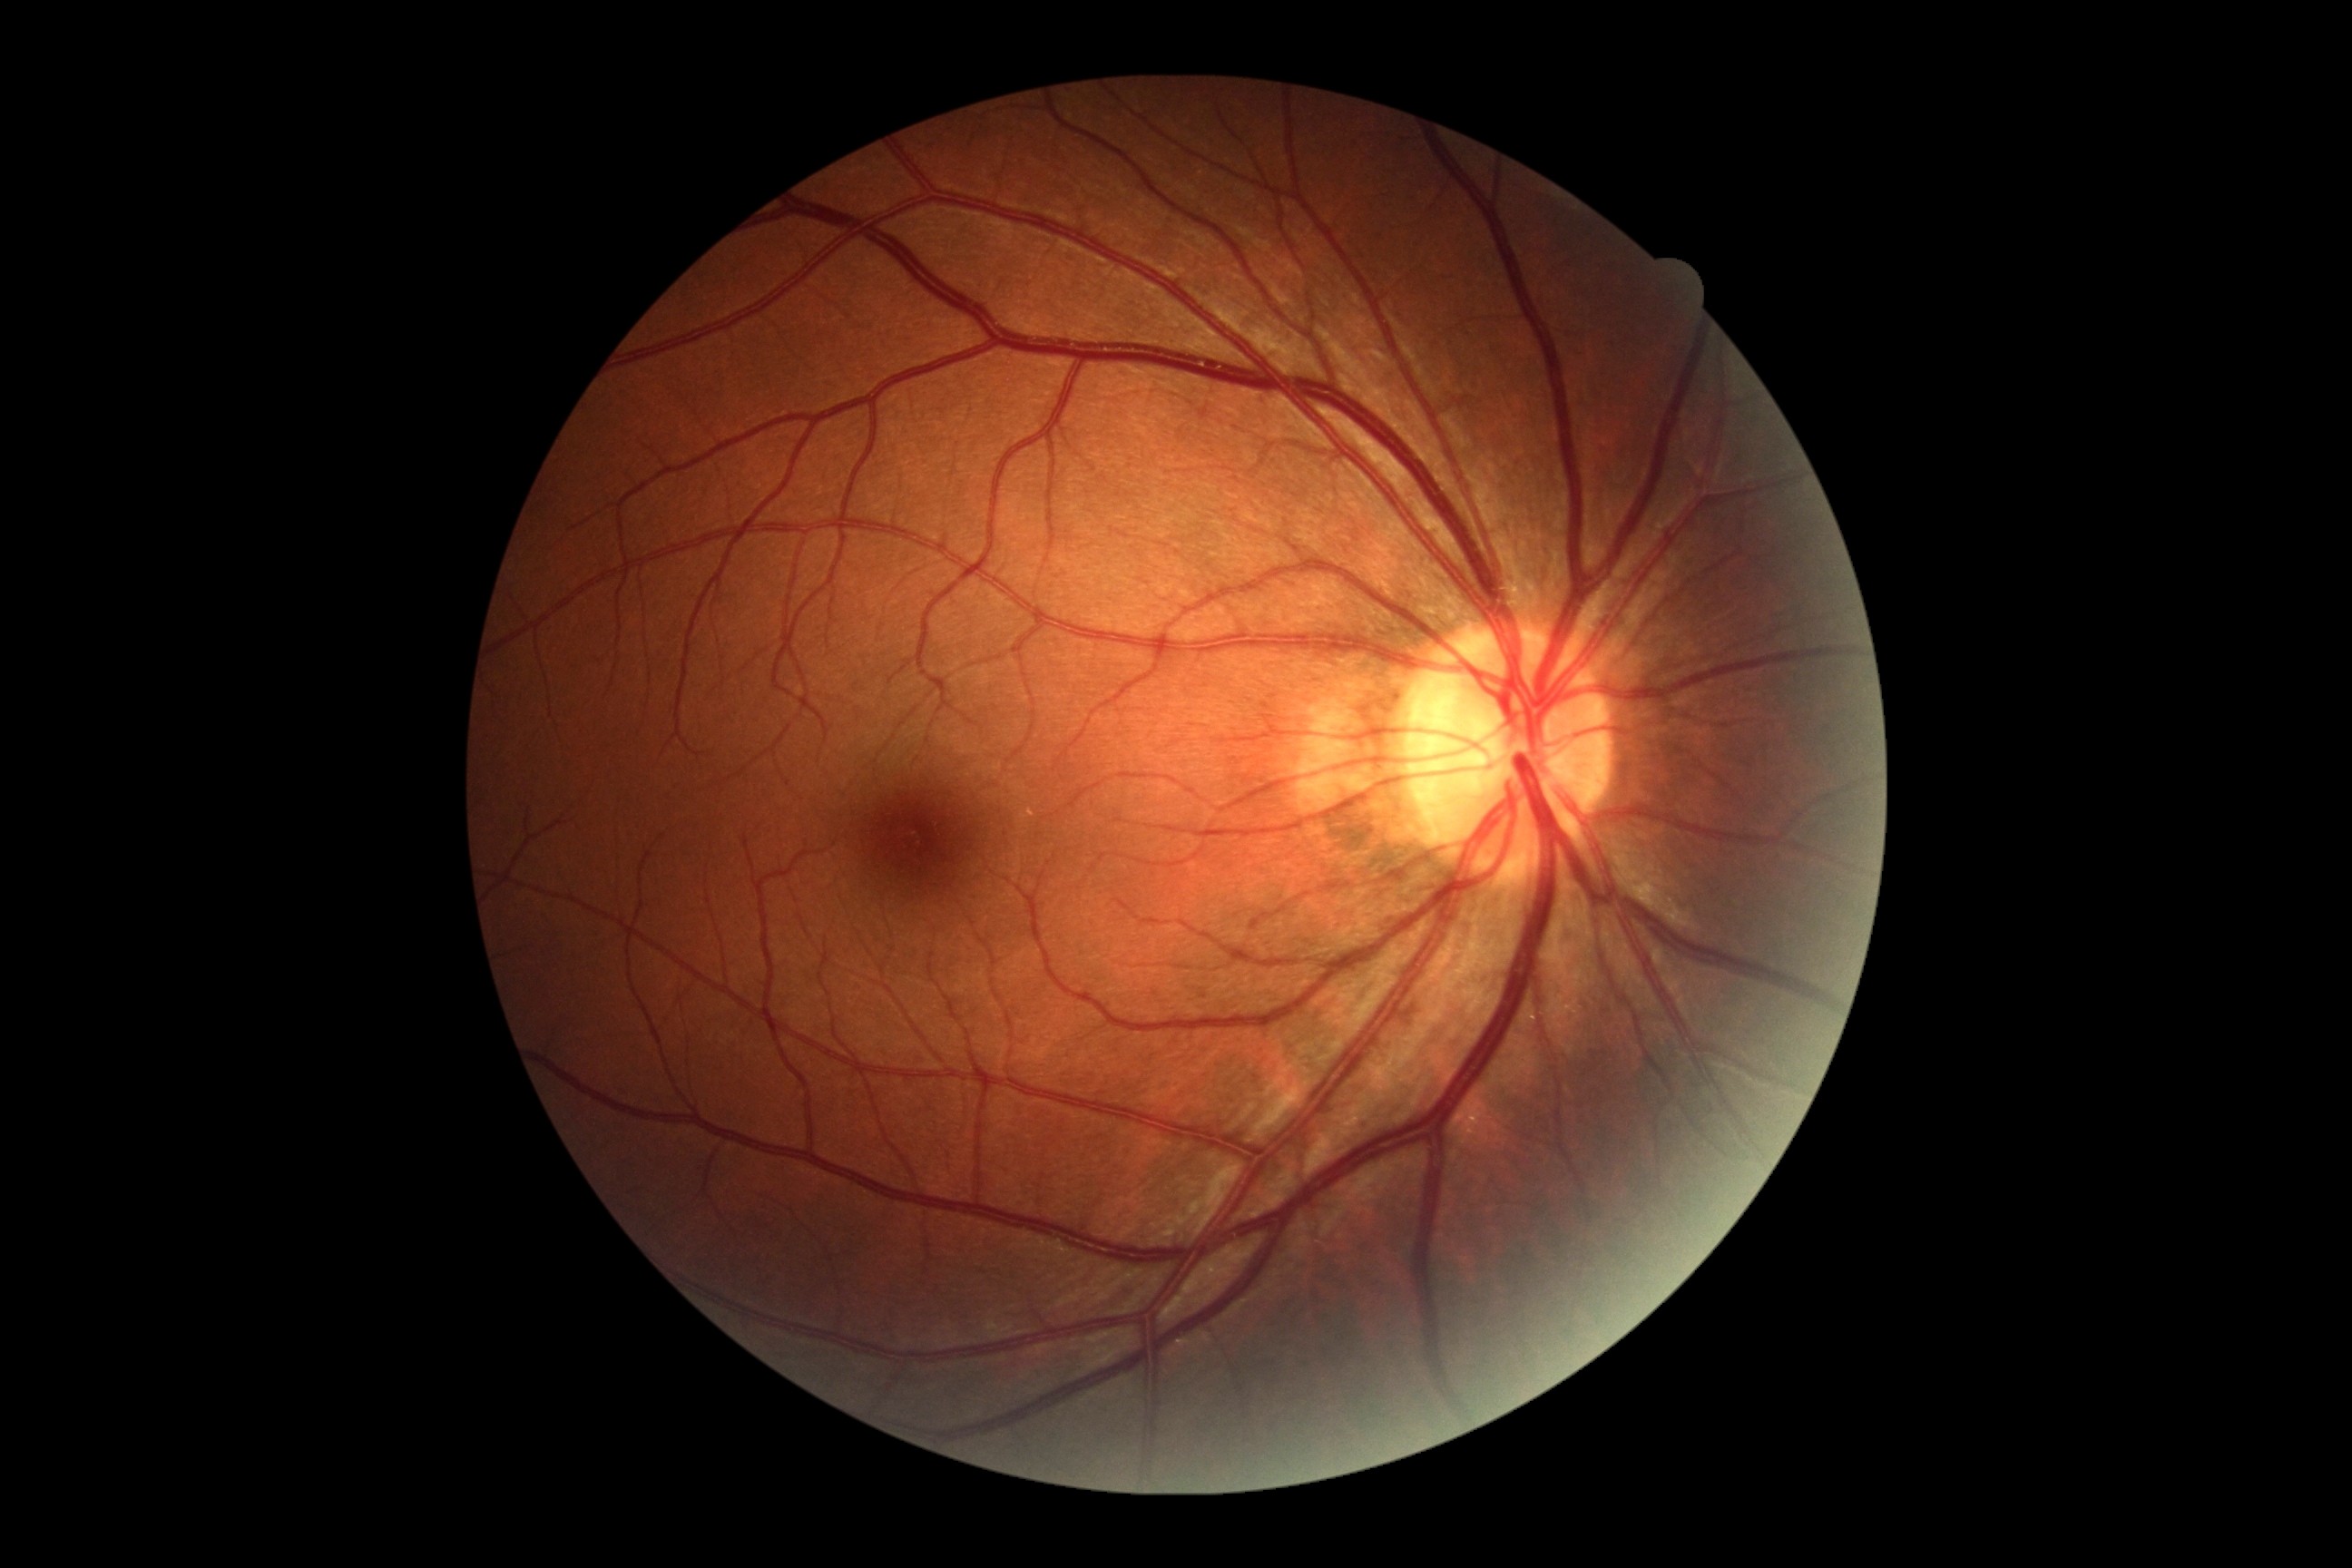

No signs of diabetic retinopathy.
DR stage: 0.